No pharmacologic dilation; 848 by 848 pixels; retinal fundus photograph; acquired with a NIDEK AFC-230; 45 degree fundus photograph — 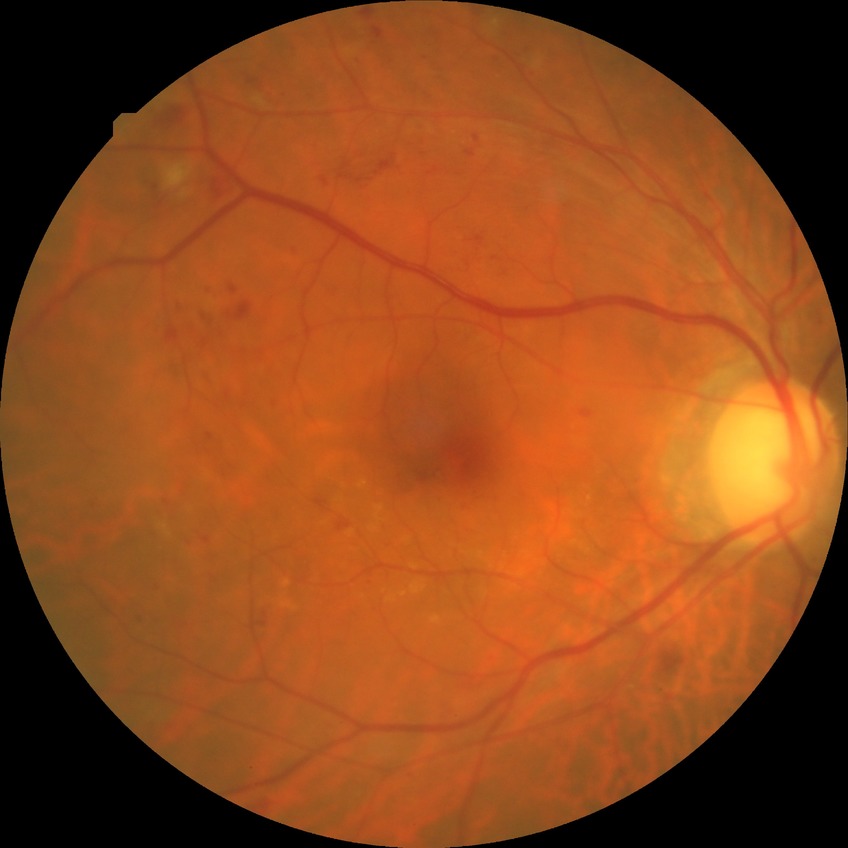 DR stage = SDR | DR class = non-proliferative diabetic retinopathy.